412x310: 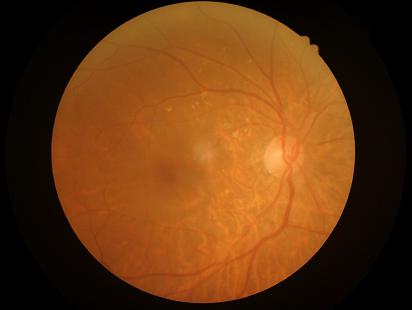

Adequate contrast for distinguishing structures. No over- or under-exposure. Acceptable image quality. Image is sharp throughout the field.